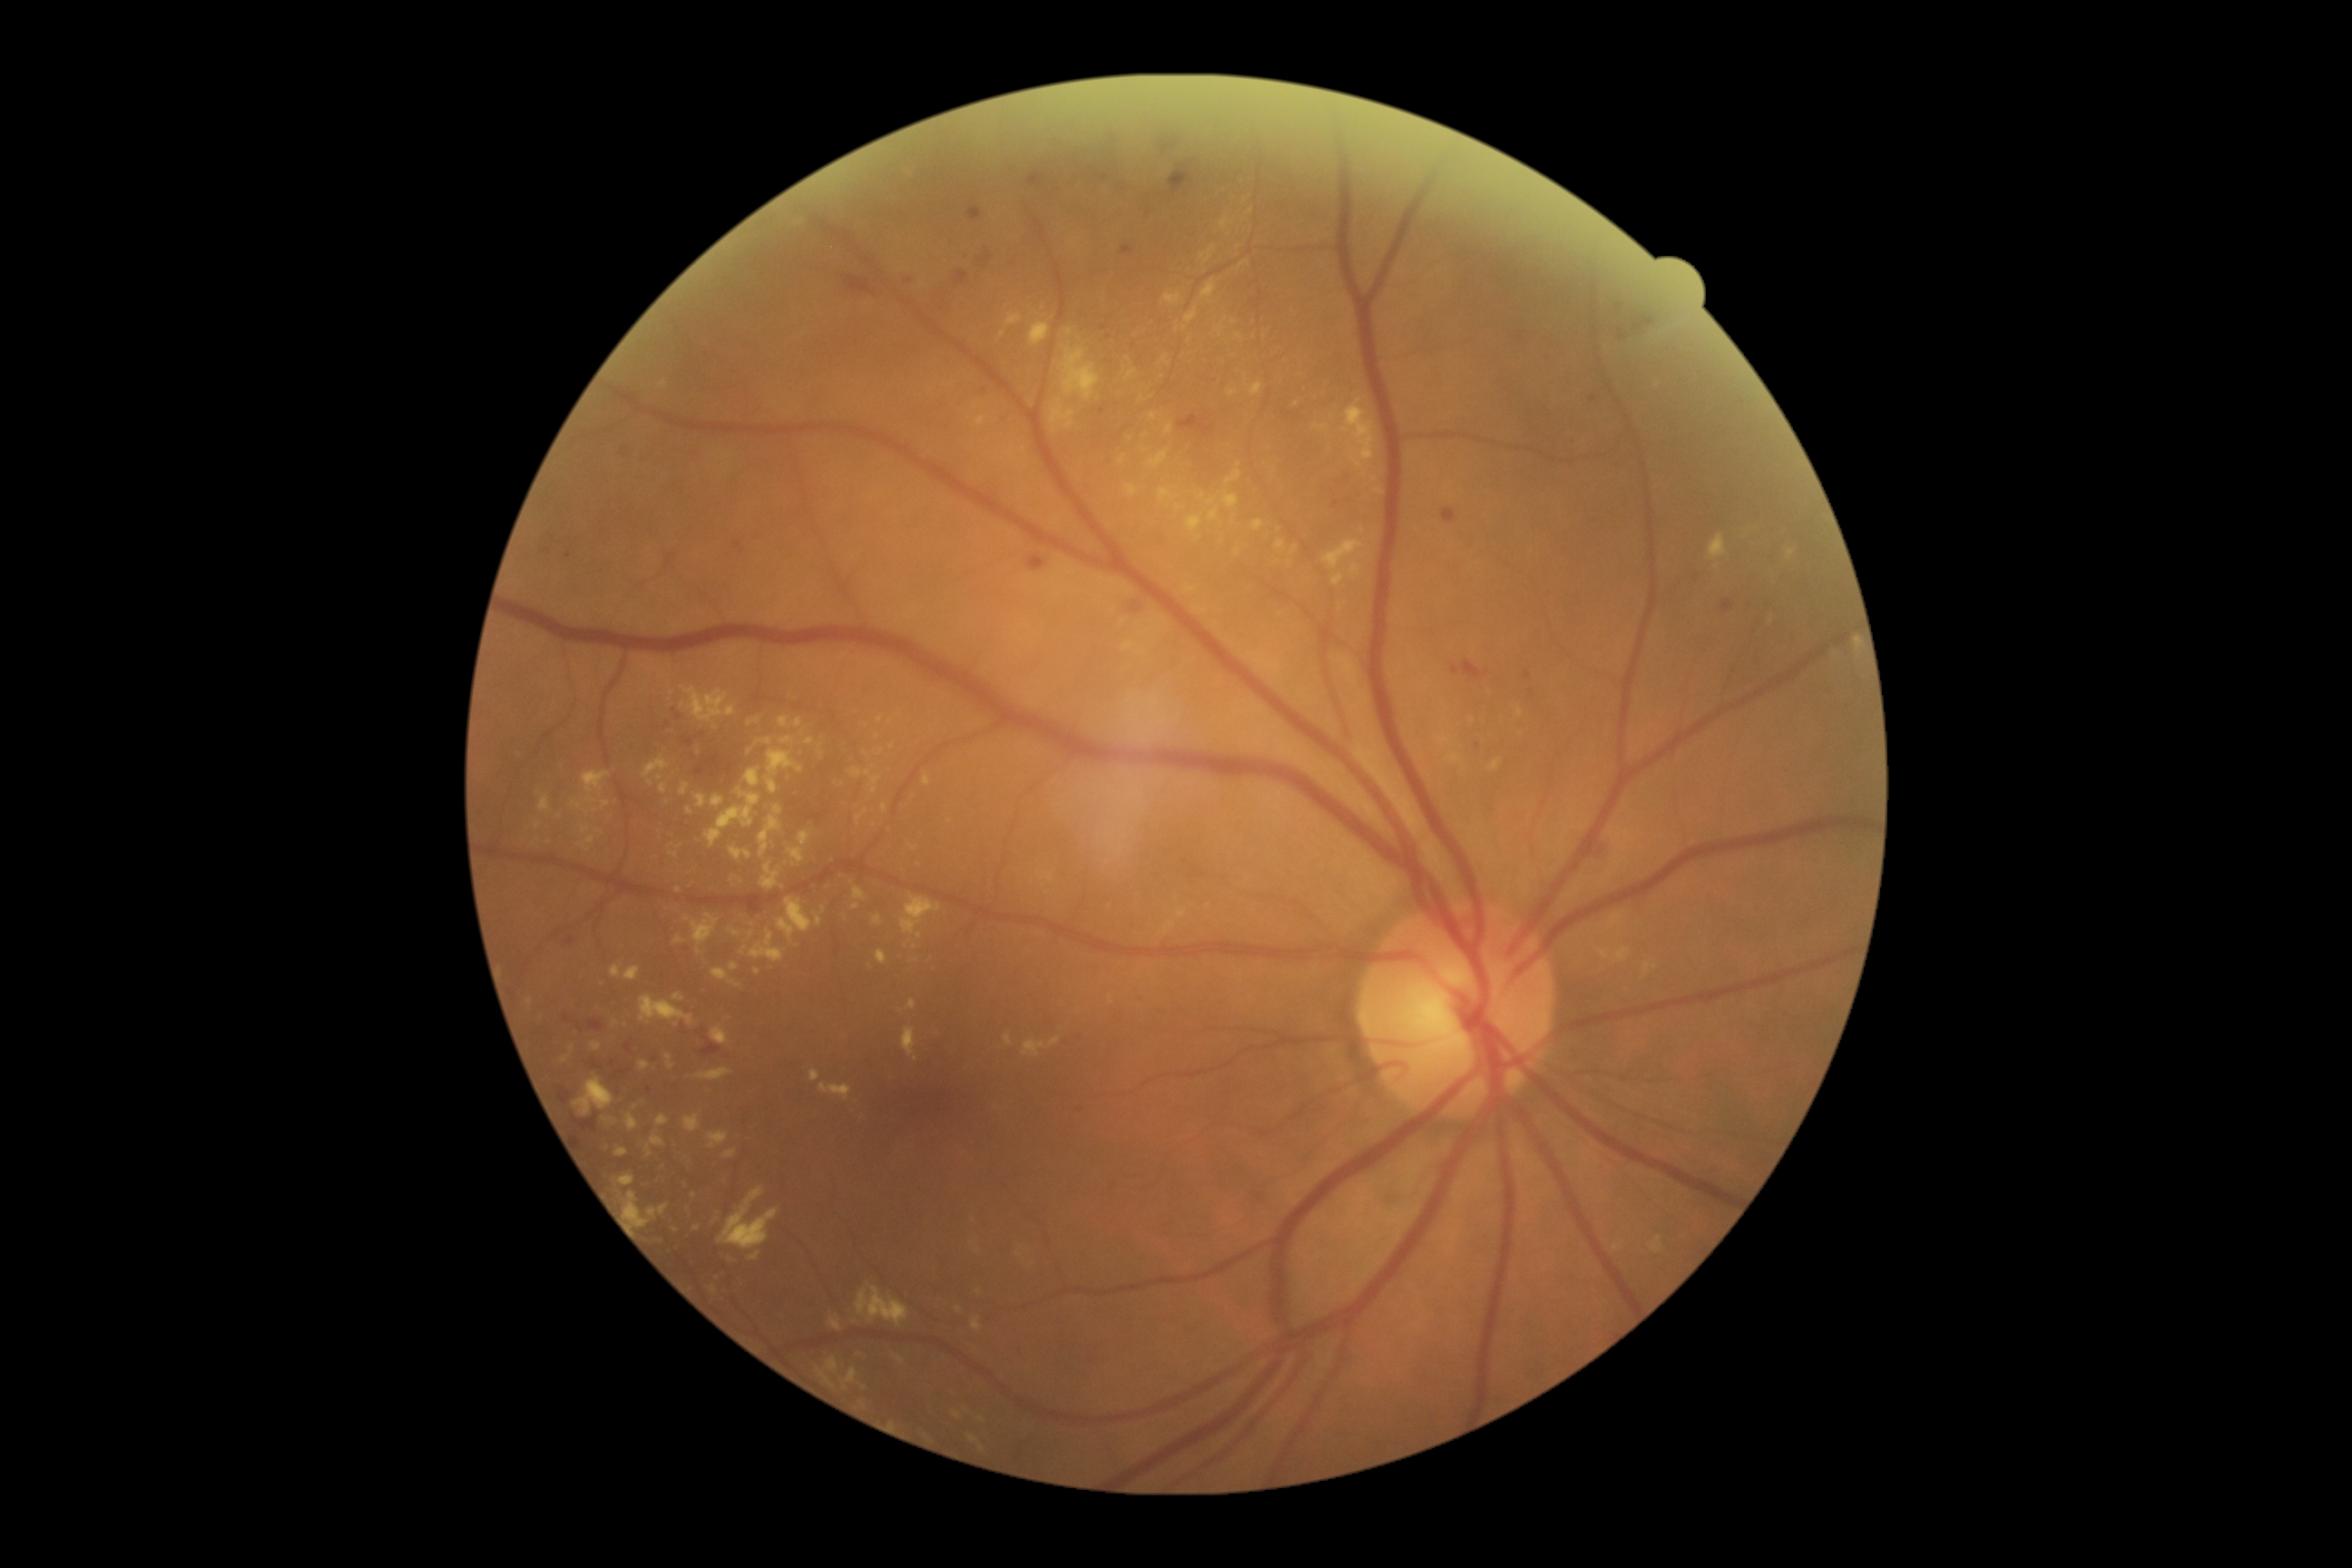
partial: true
dr_grade: 2
dr_grade_name: moderate NPDR
lesions:
  ex:
    - [571, 801, 582, 808]
    - [651, 1135, 665, 1148]
    - [1188, 514, 1202, 531]
    - [1177, 910, 1188, 919]
    - [756, 738, 774, 747]
    - [574, 1077, 614, 1117]
    - [712, 968, 741, 988]
    - [1240, 262, 1250, 270]
    - [745, 769, 761, 789]
    - [779, 716, 789, 729]
    - [810, 1070, 821, 1083]
  ex_small:
    - x=587 y=814
    - x=1153 y=416
    - x=1234 y=323
    - x=1002 y=335
    - x=673 y=693
    - x=890 y=722
    - x=1051 y=879